Color fundus photograph: 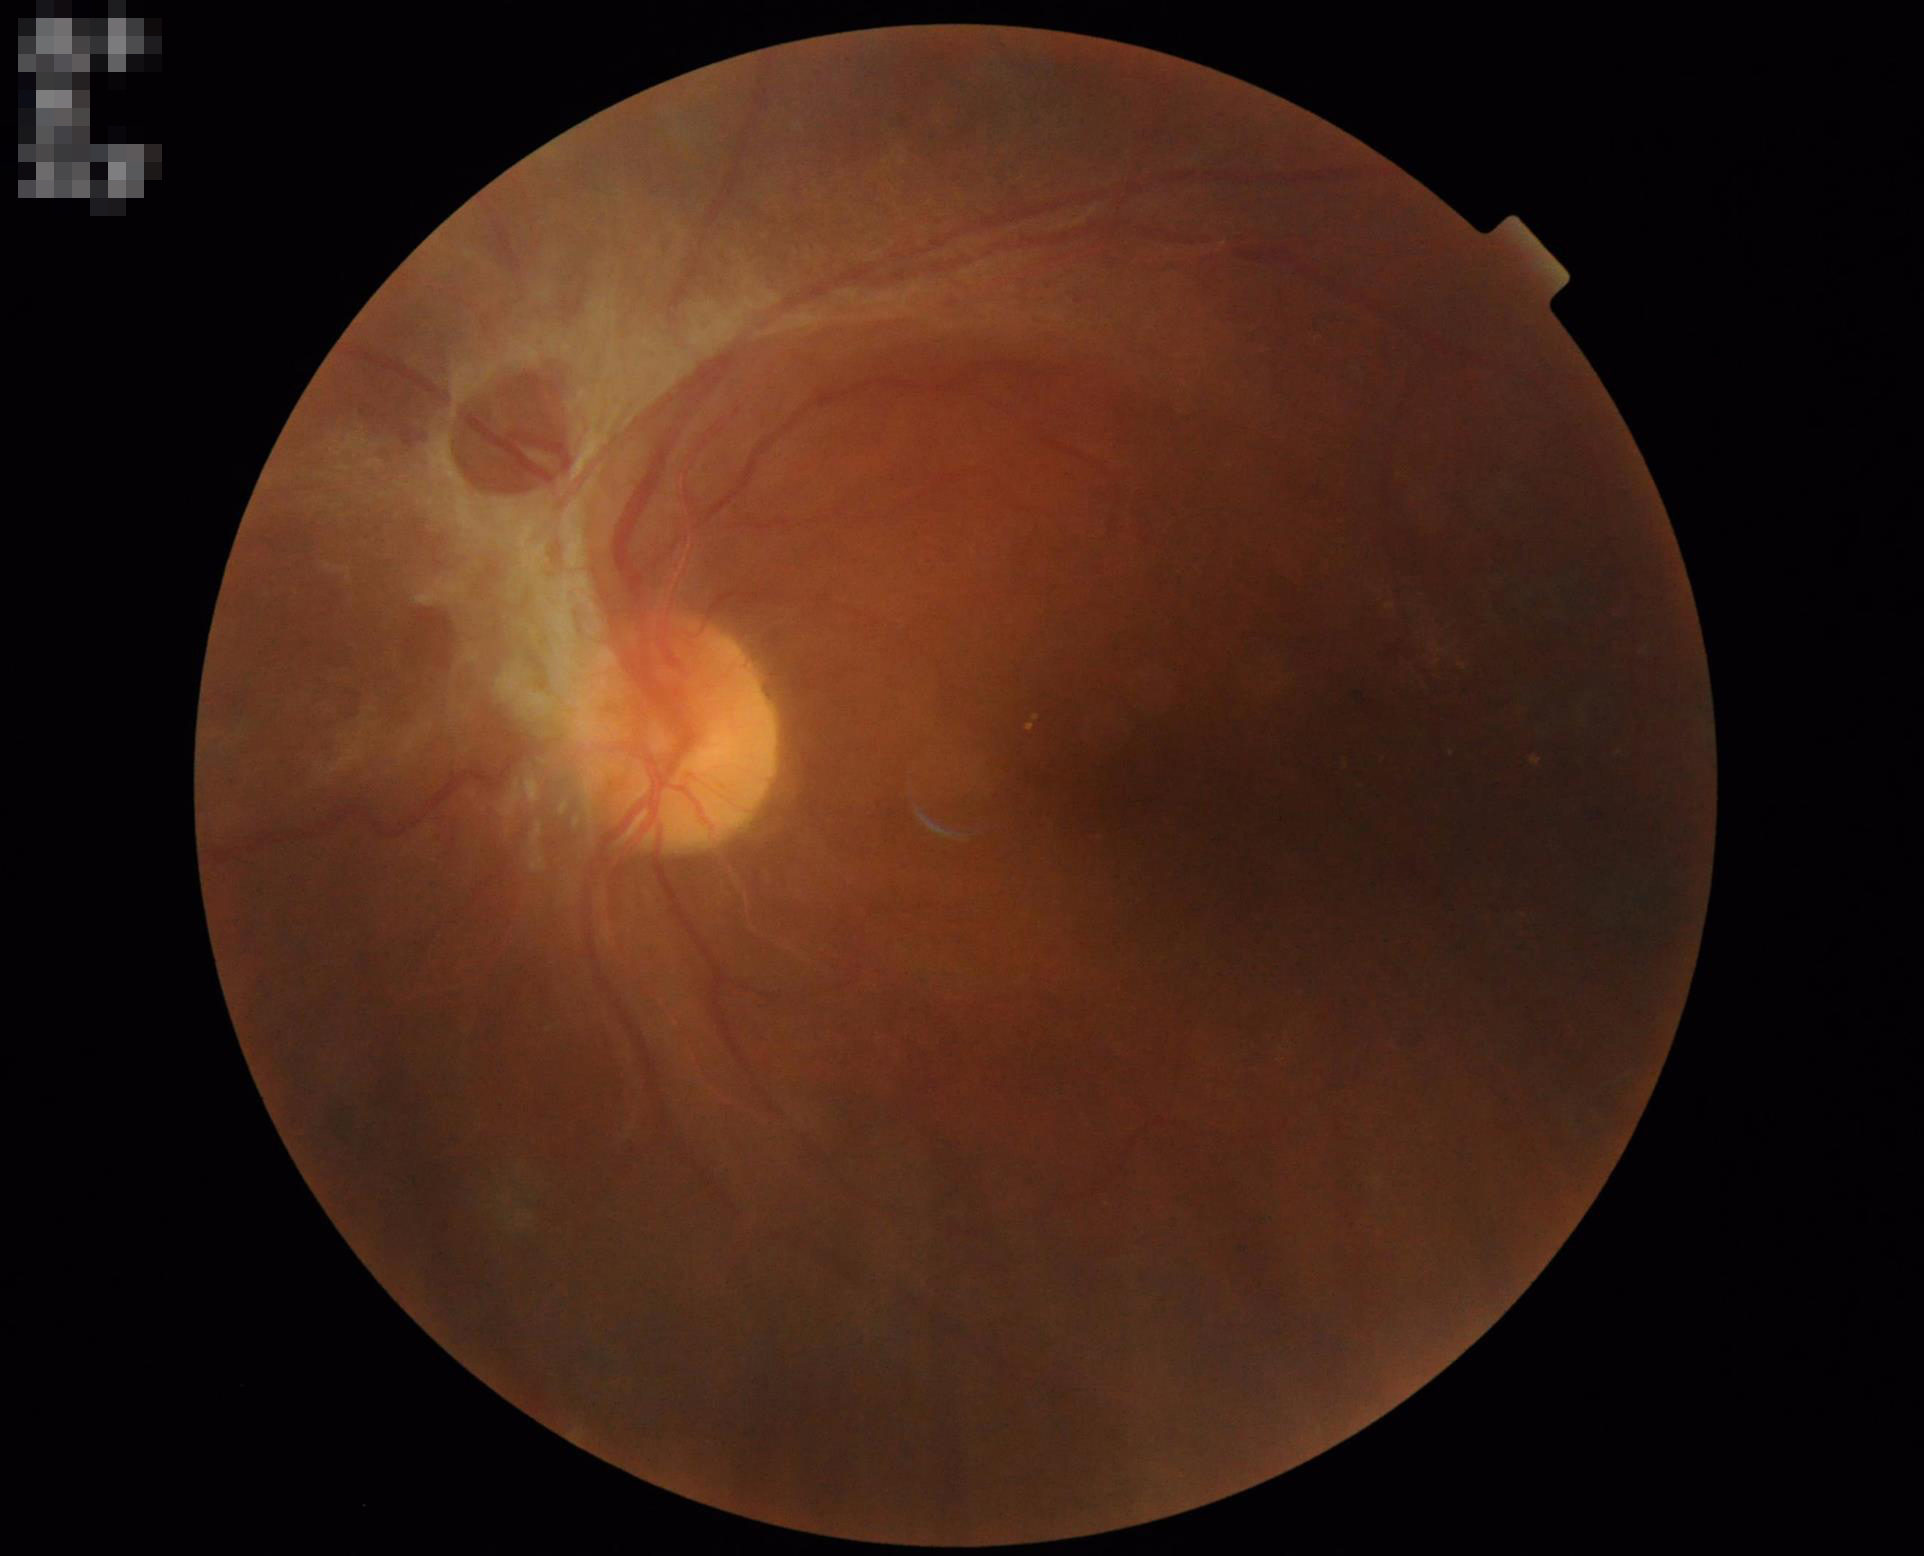

Image quality assessment: illumination/color: over- or under-exposed; clarity: clear with no noticeable blur; contrast: good dynamic range; overall: inadequate for clinical interpretation.